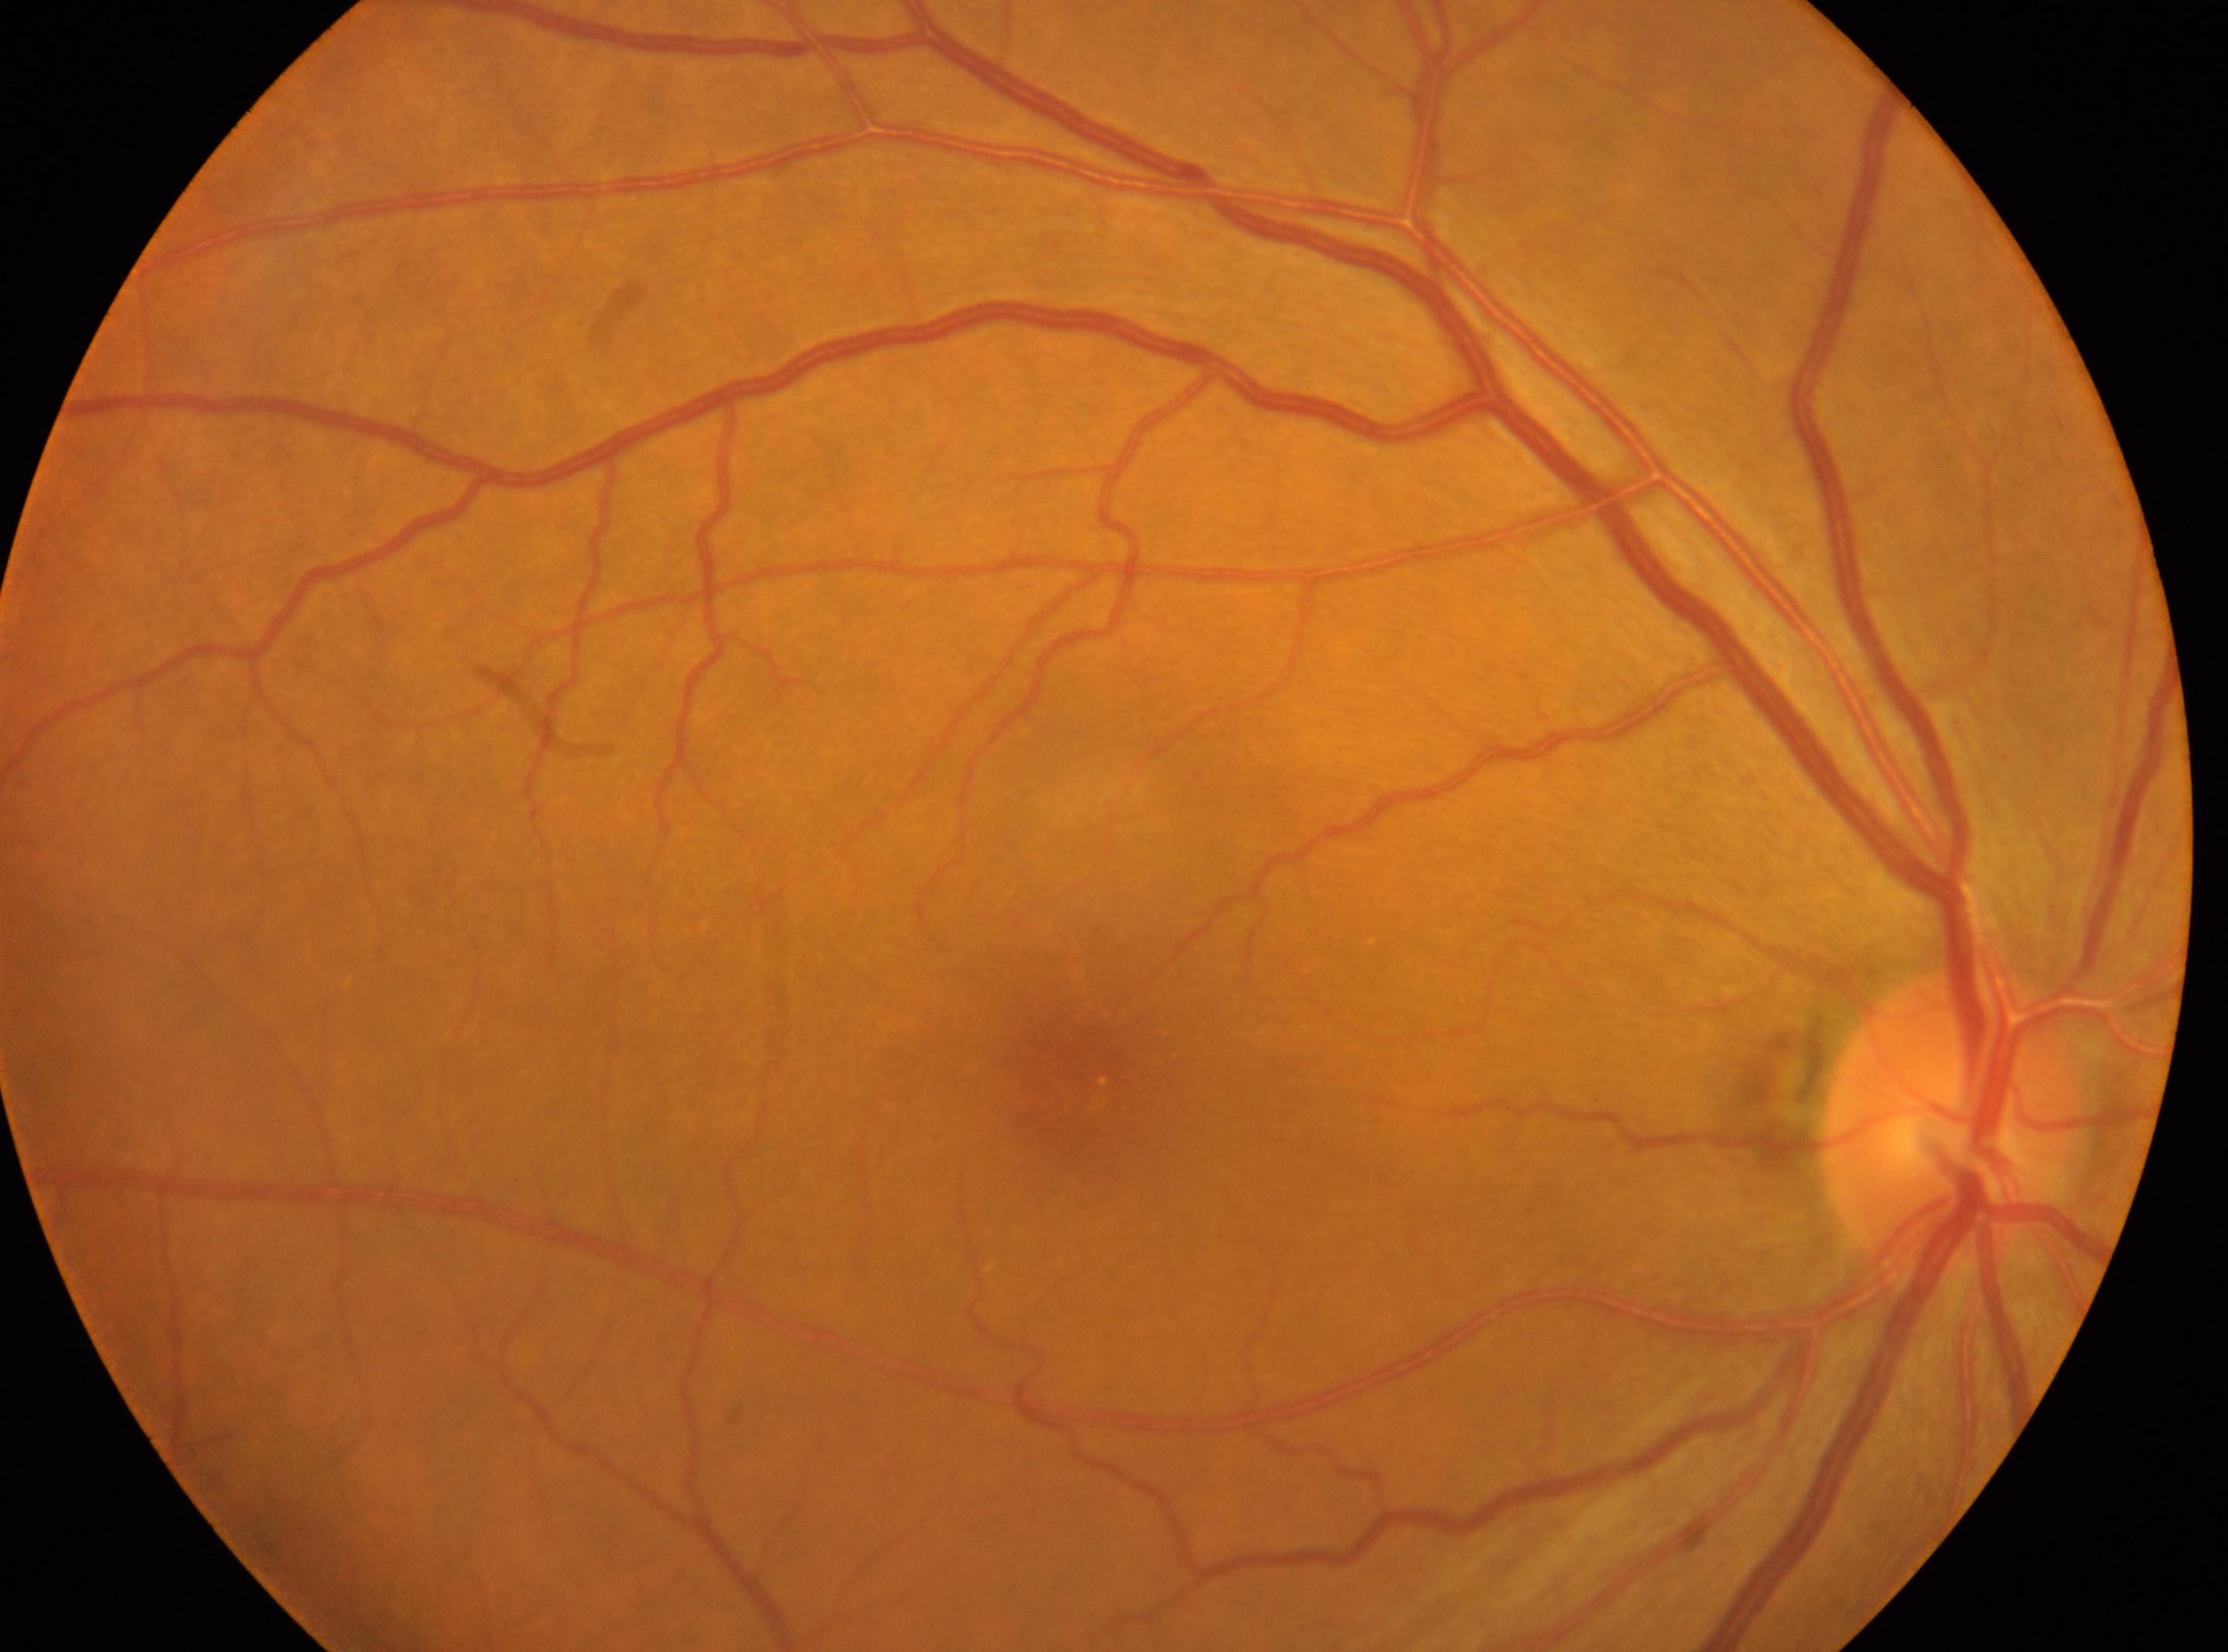 Annotations:
- optic disc center · (x=1950, y=1120)
- laterality · right eye
- DR stage · grade 0
- fovea center · (x=1078, y=1067)